Image size 2212x1659:
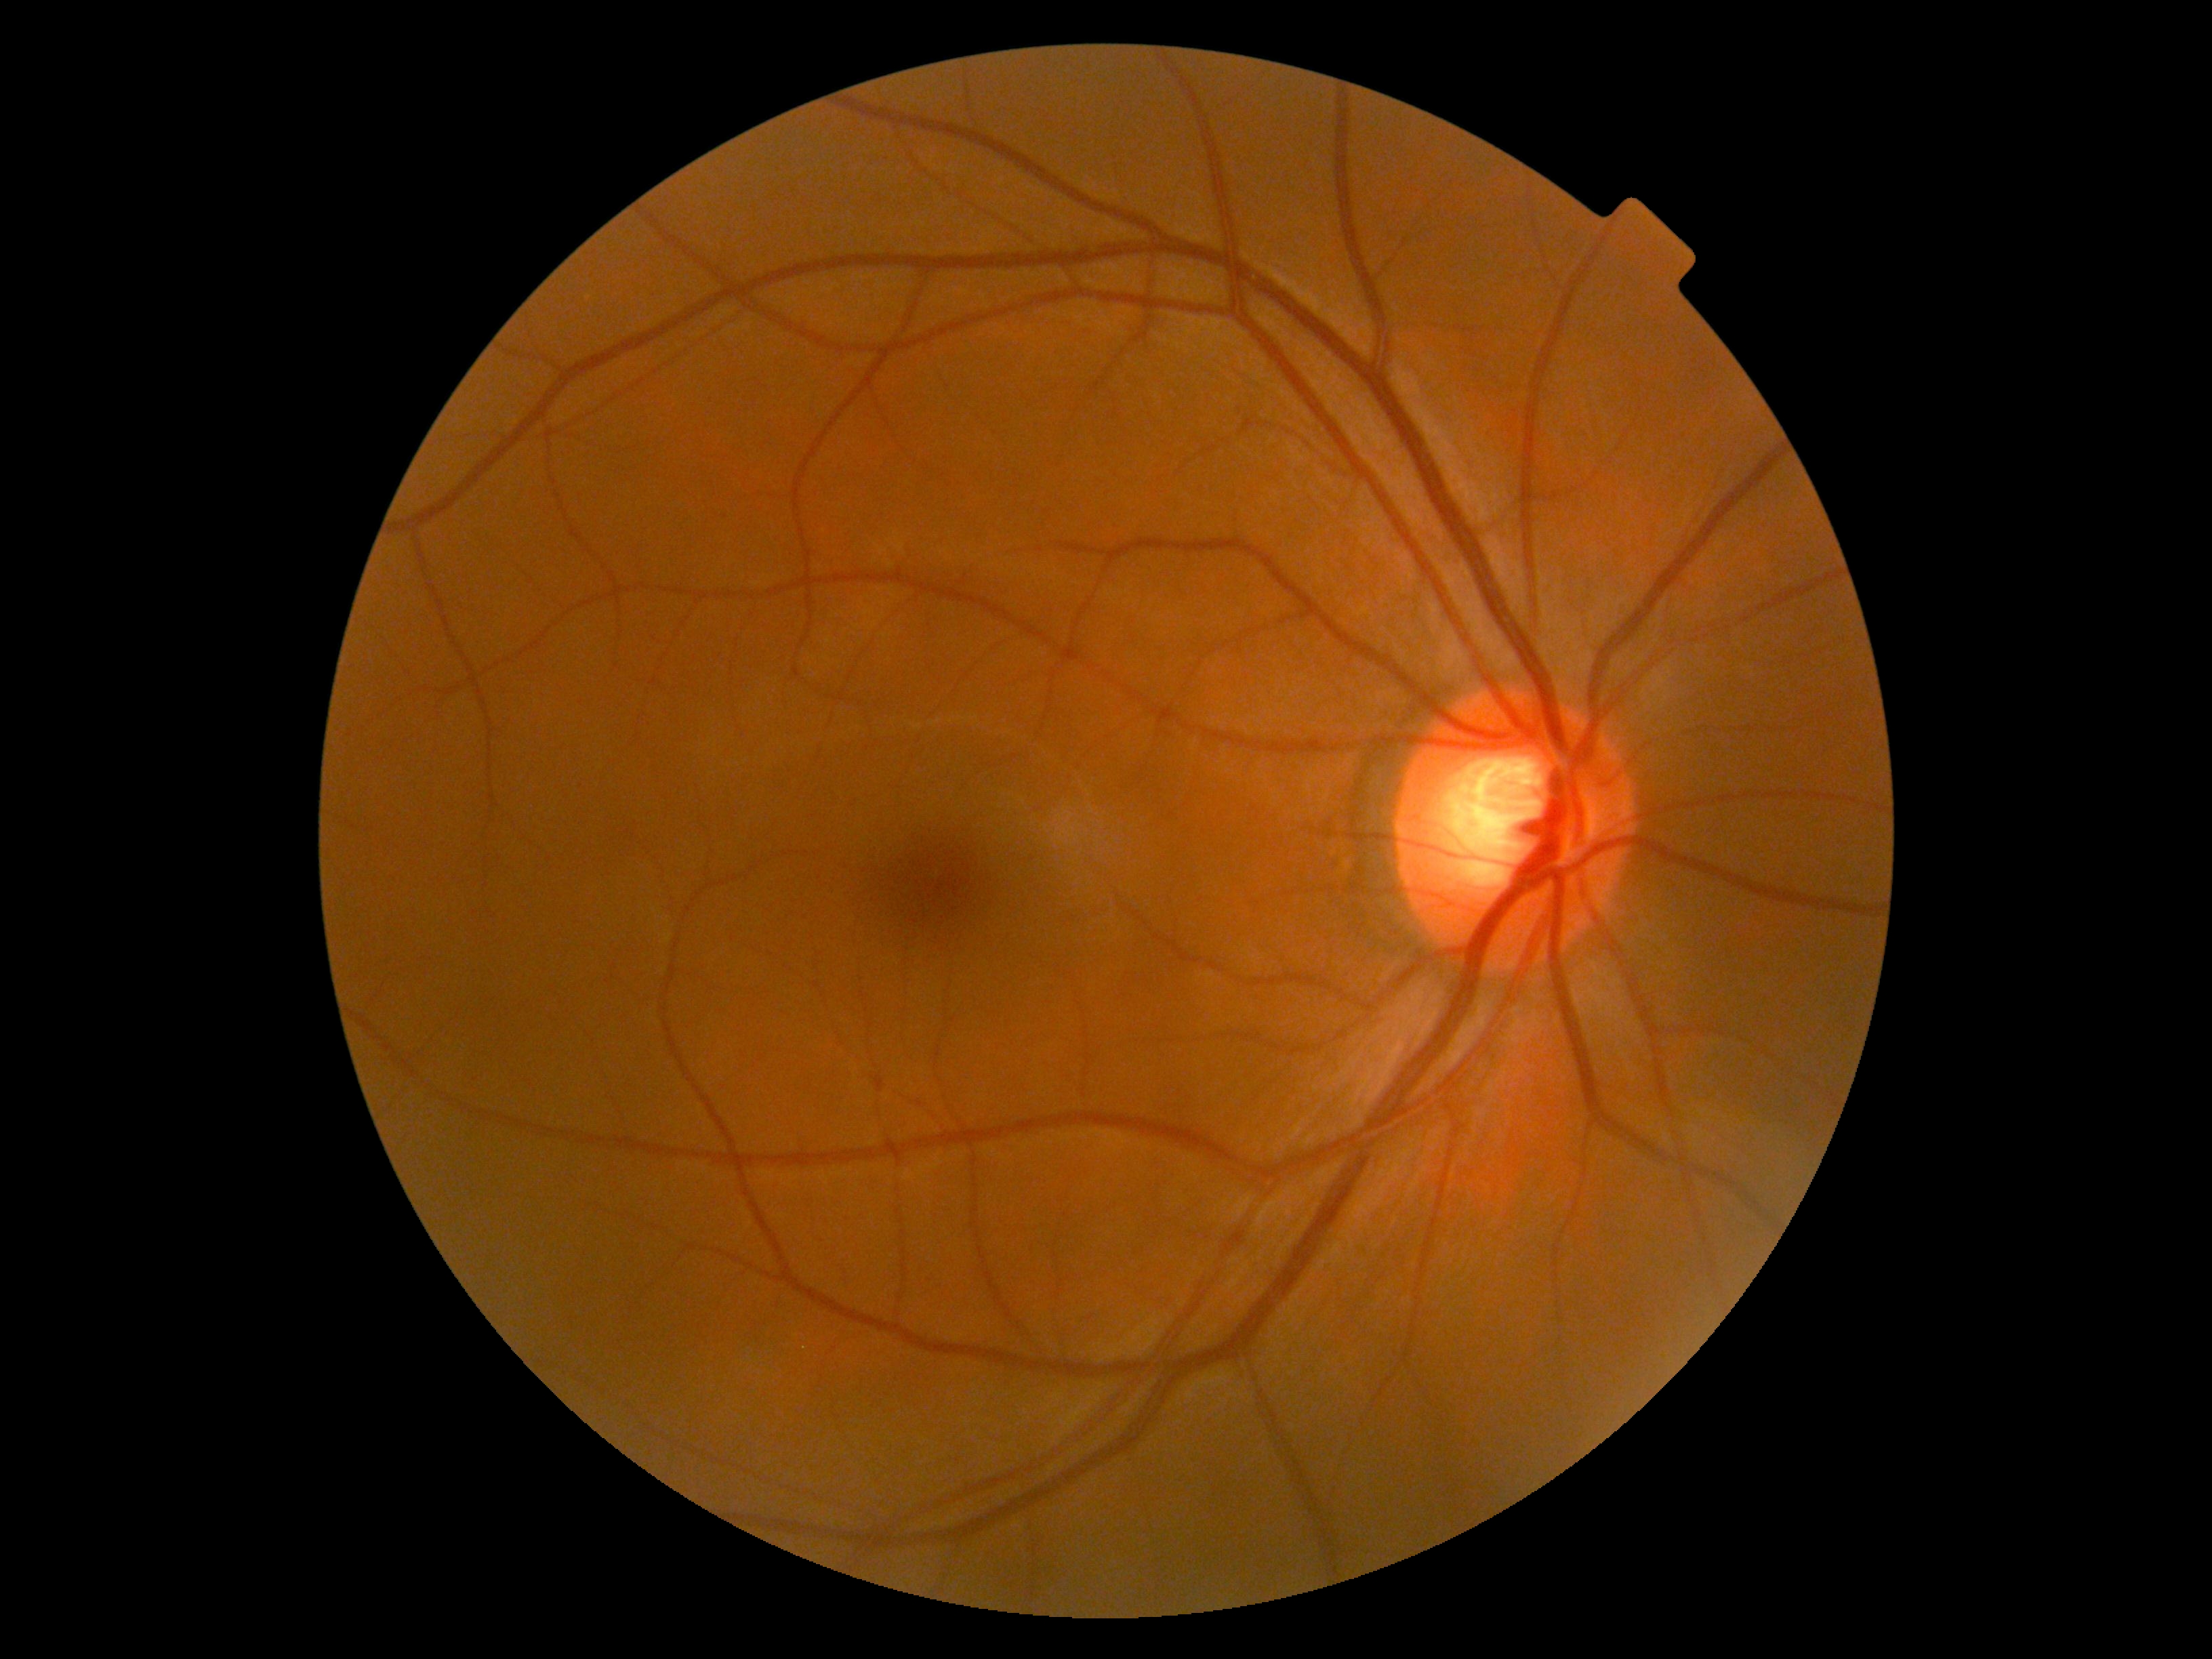 No diabetic retinal disease findings.
Diabetic retinopathy (DR) is grade 0 (no apparent retinopathy).